Camera: NIDEK AFC-230; 45-degree field of view; 848 x 848 pixels: 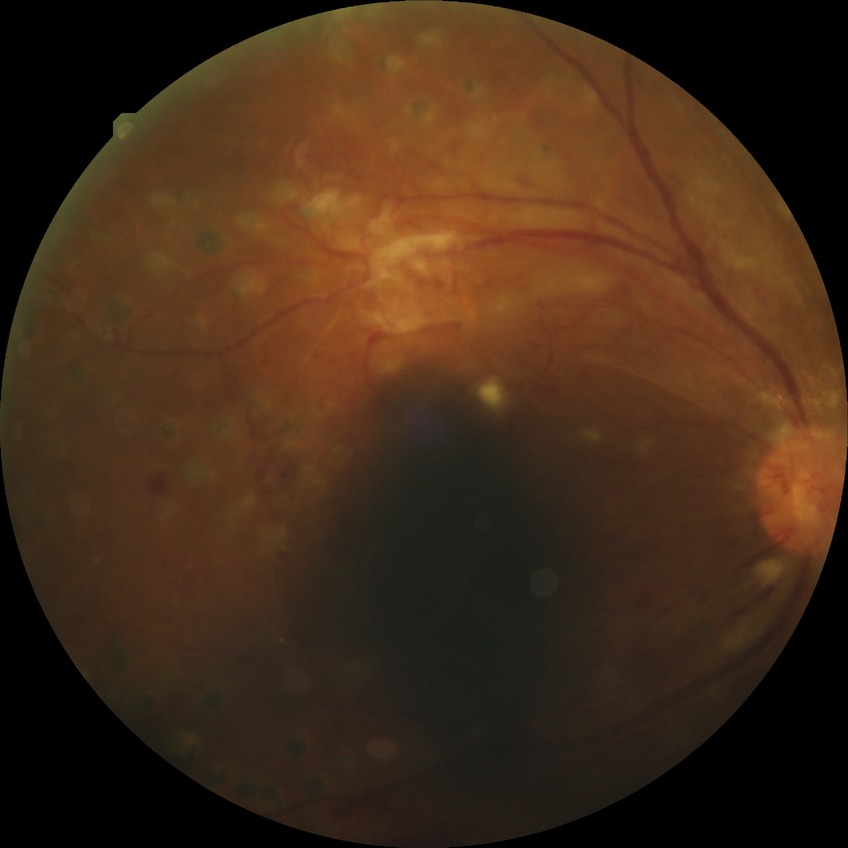 Retinopathy grade: proliferative diabetic retinopathy.